1240 by 1240 pixels. Phoenix ICON wide-field infant fundus image. Acquired on the Phoenix ICON:
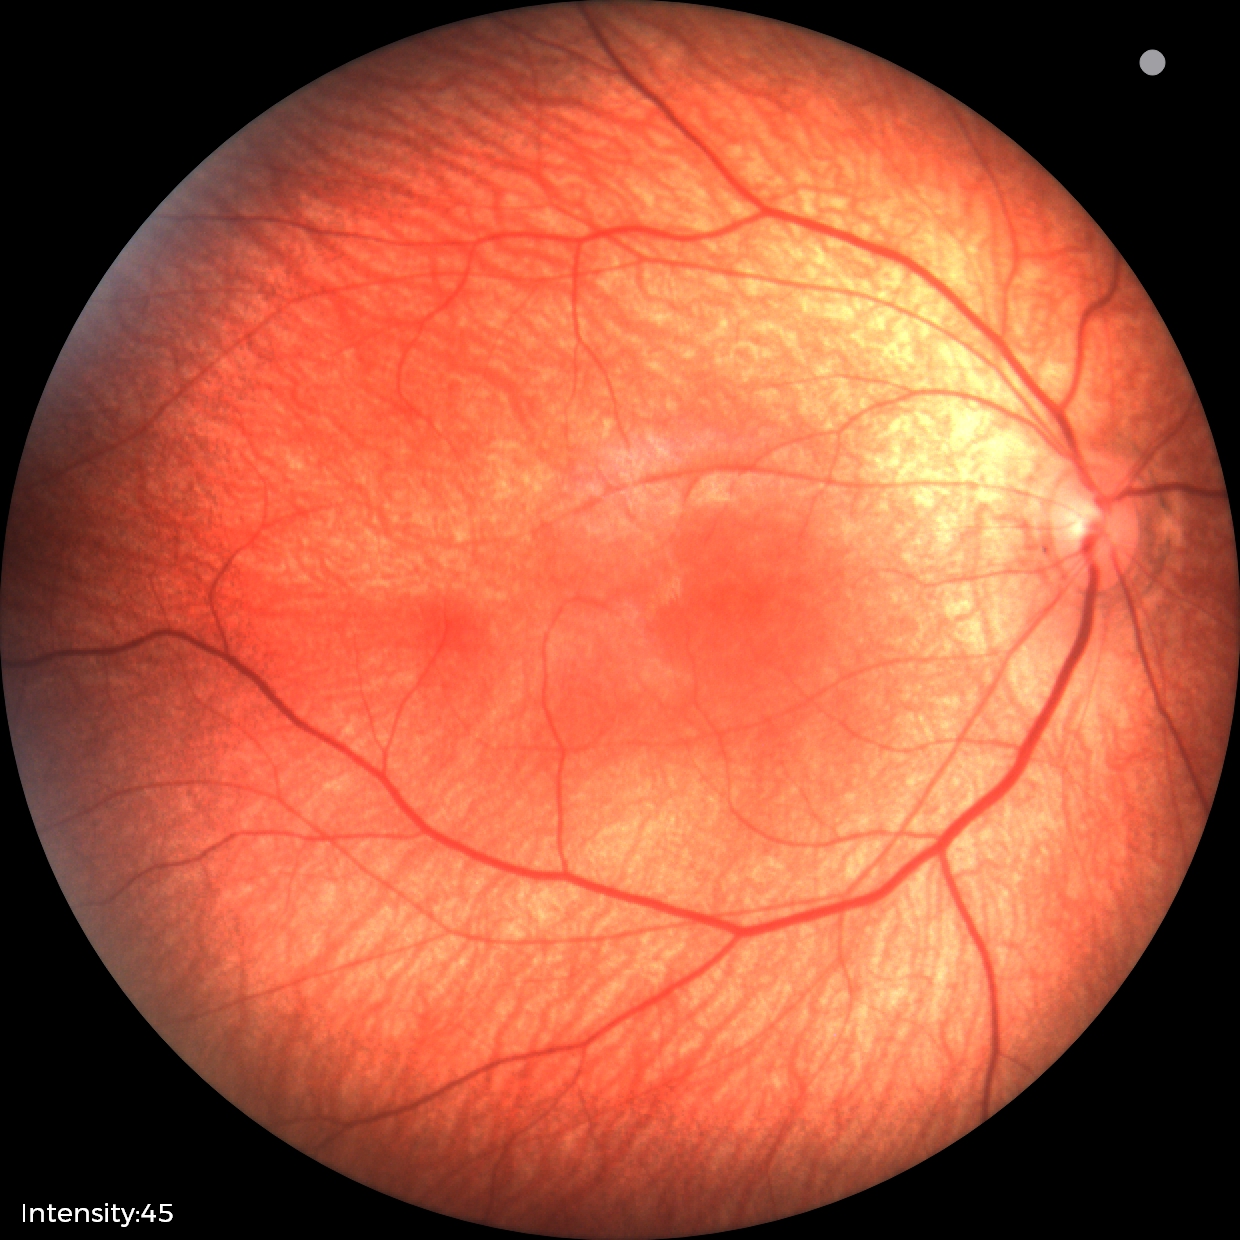 Screening: physiological appearance with no retinal pathology.